Fundus photo: 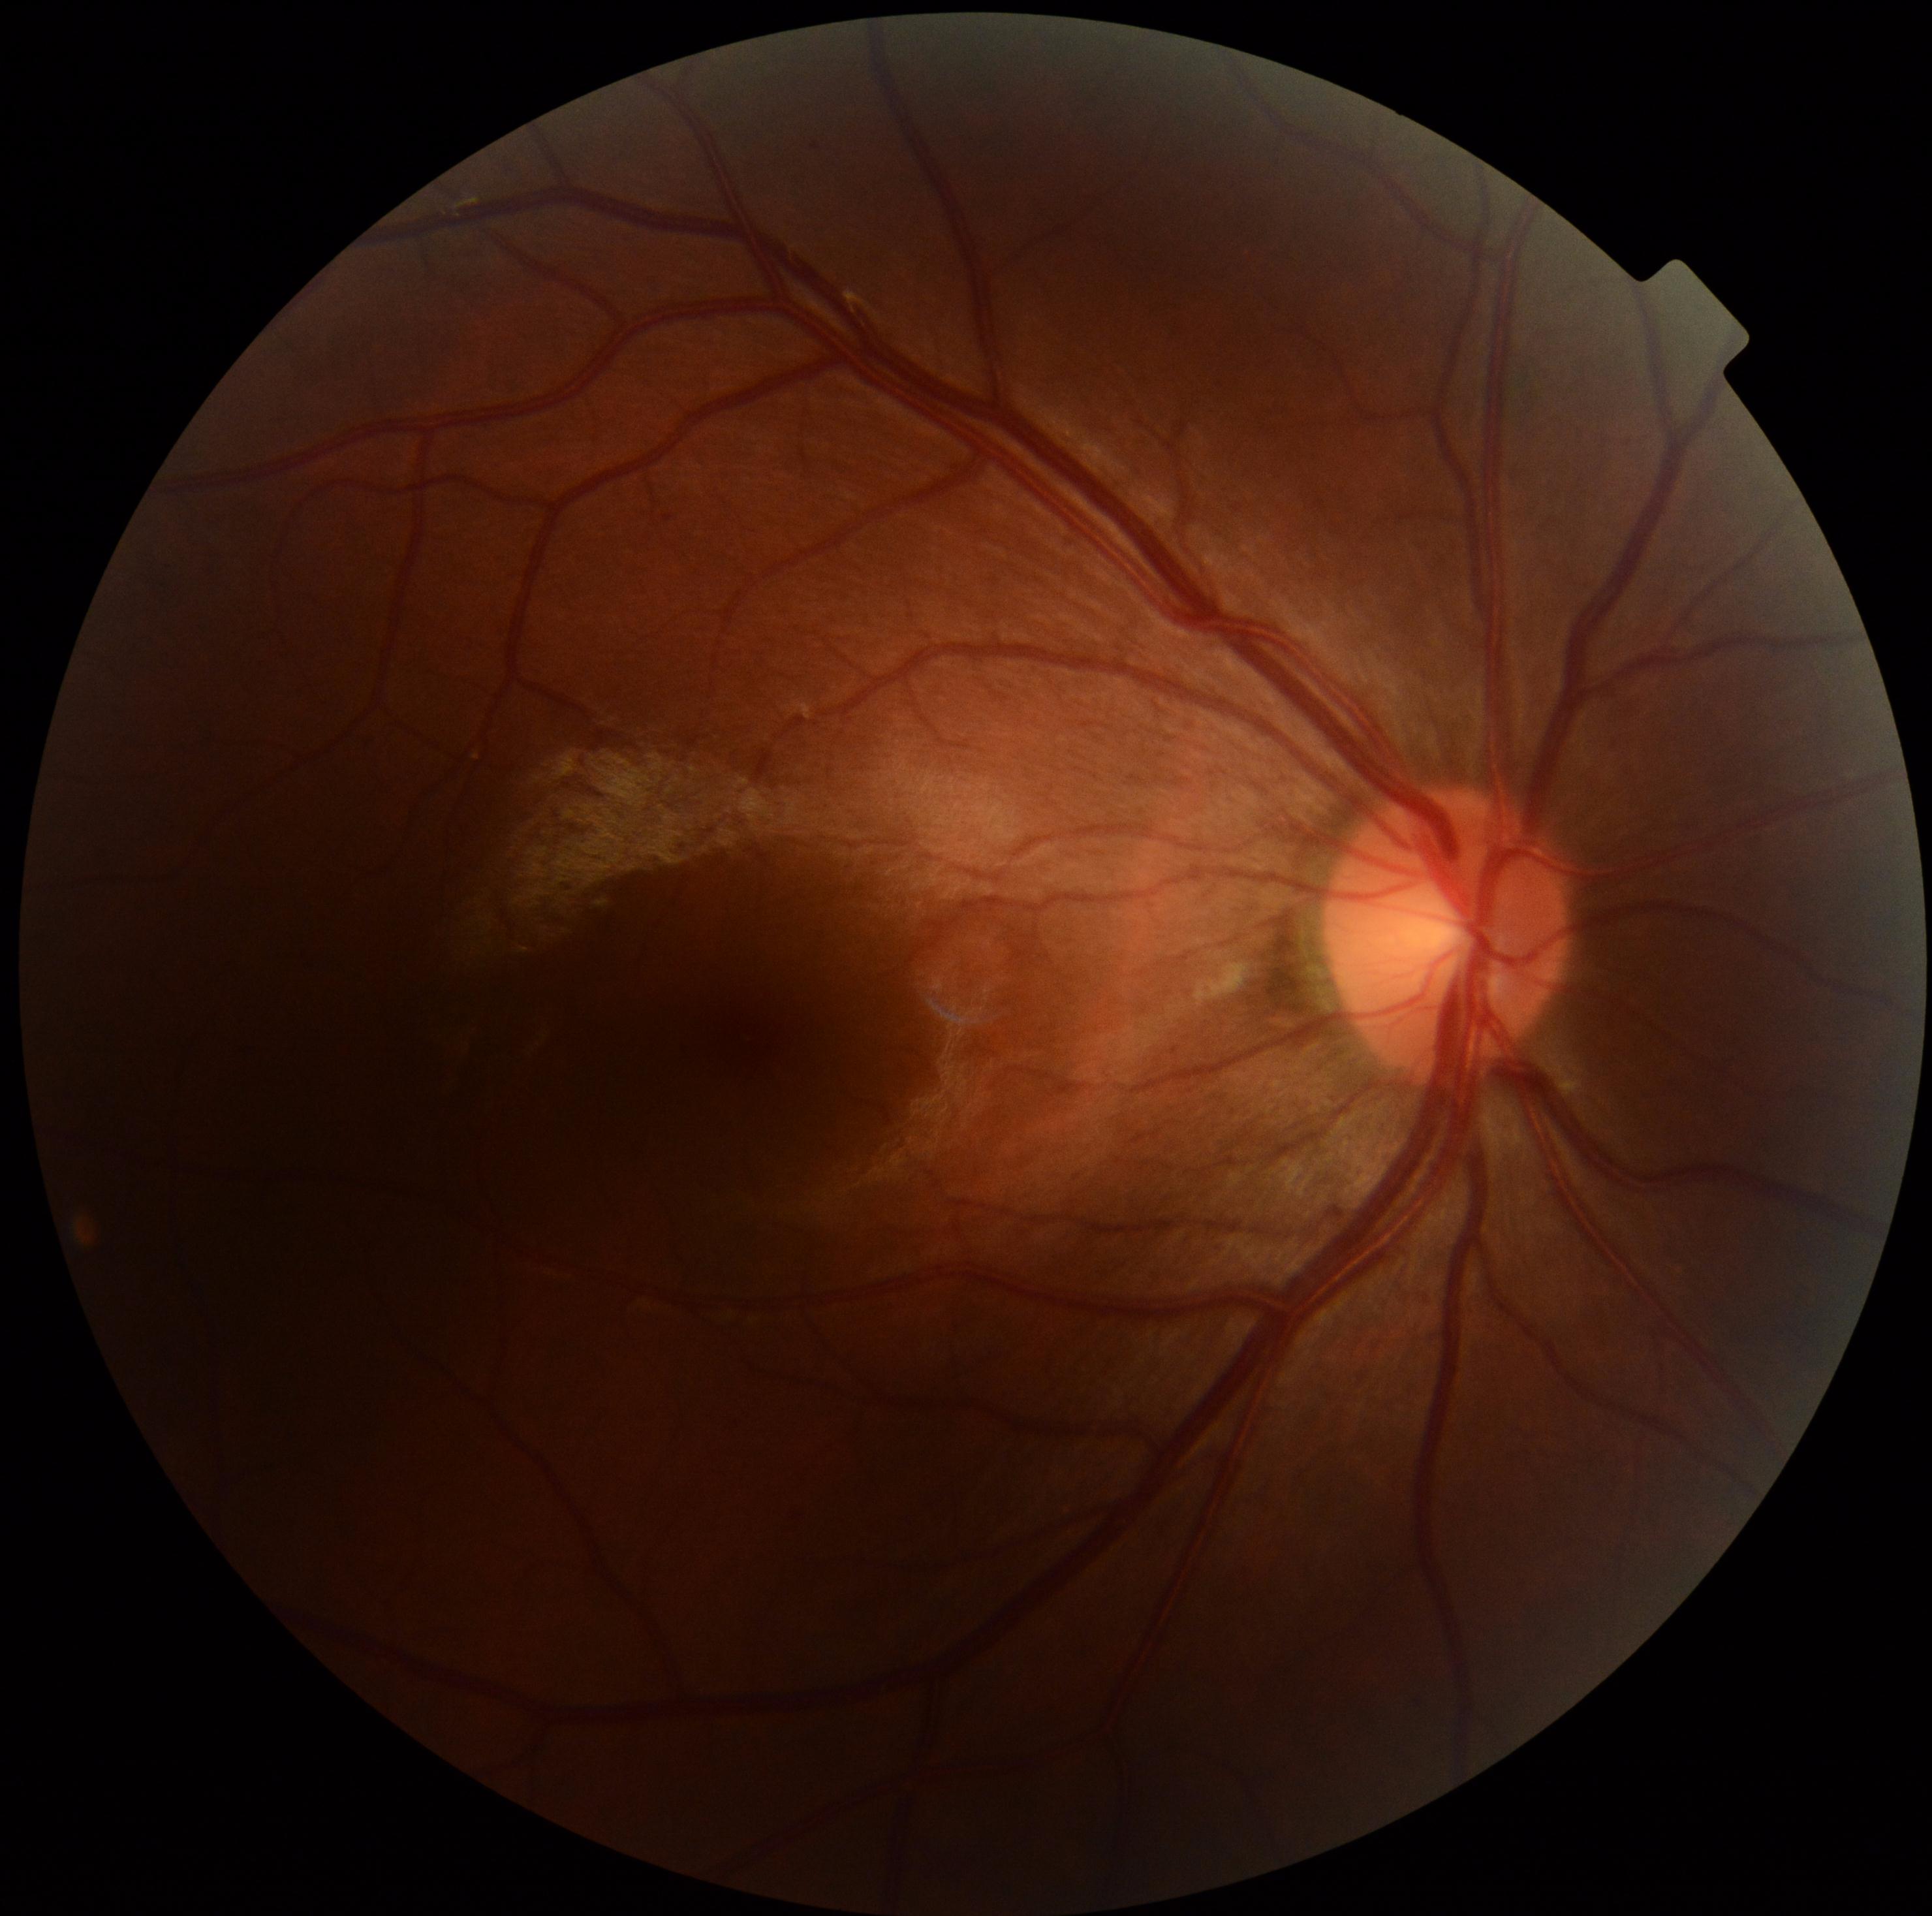
Retinopathy: grade 2 (moderate NPDR).